45° FOV; nonmydriatic fundus photograph; 848 x 848 pixels — 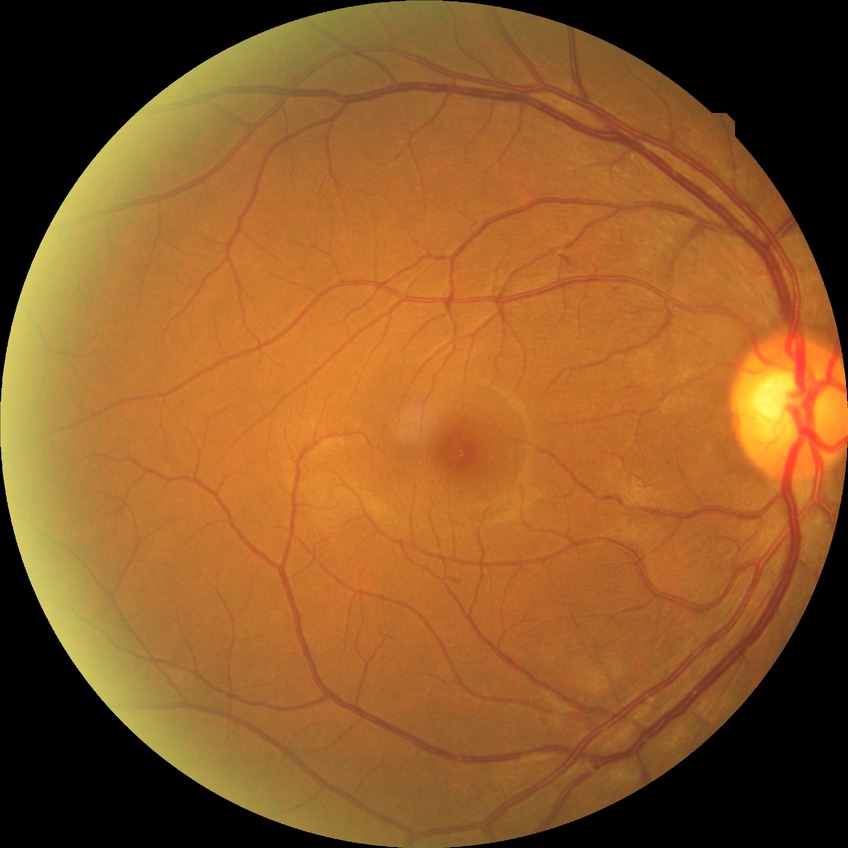

Diabetic retinopathy (DR) is simple diabetic retinopathy (SDR).